45° FOV
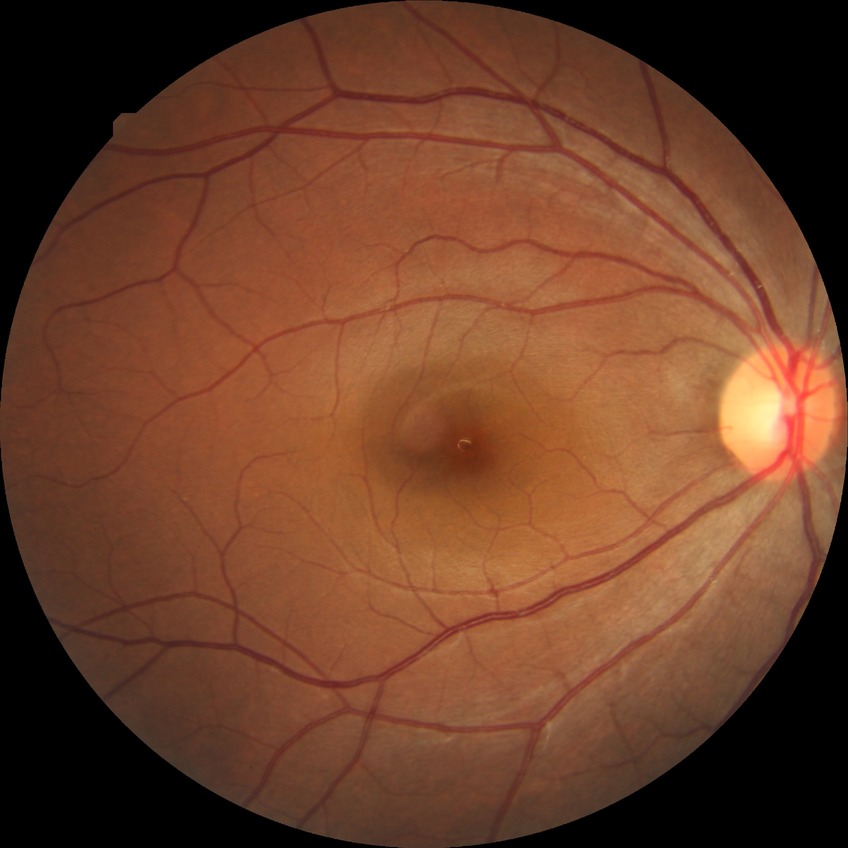 Modified Davis grading: no diabetic retinopathy.